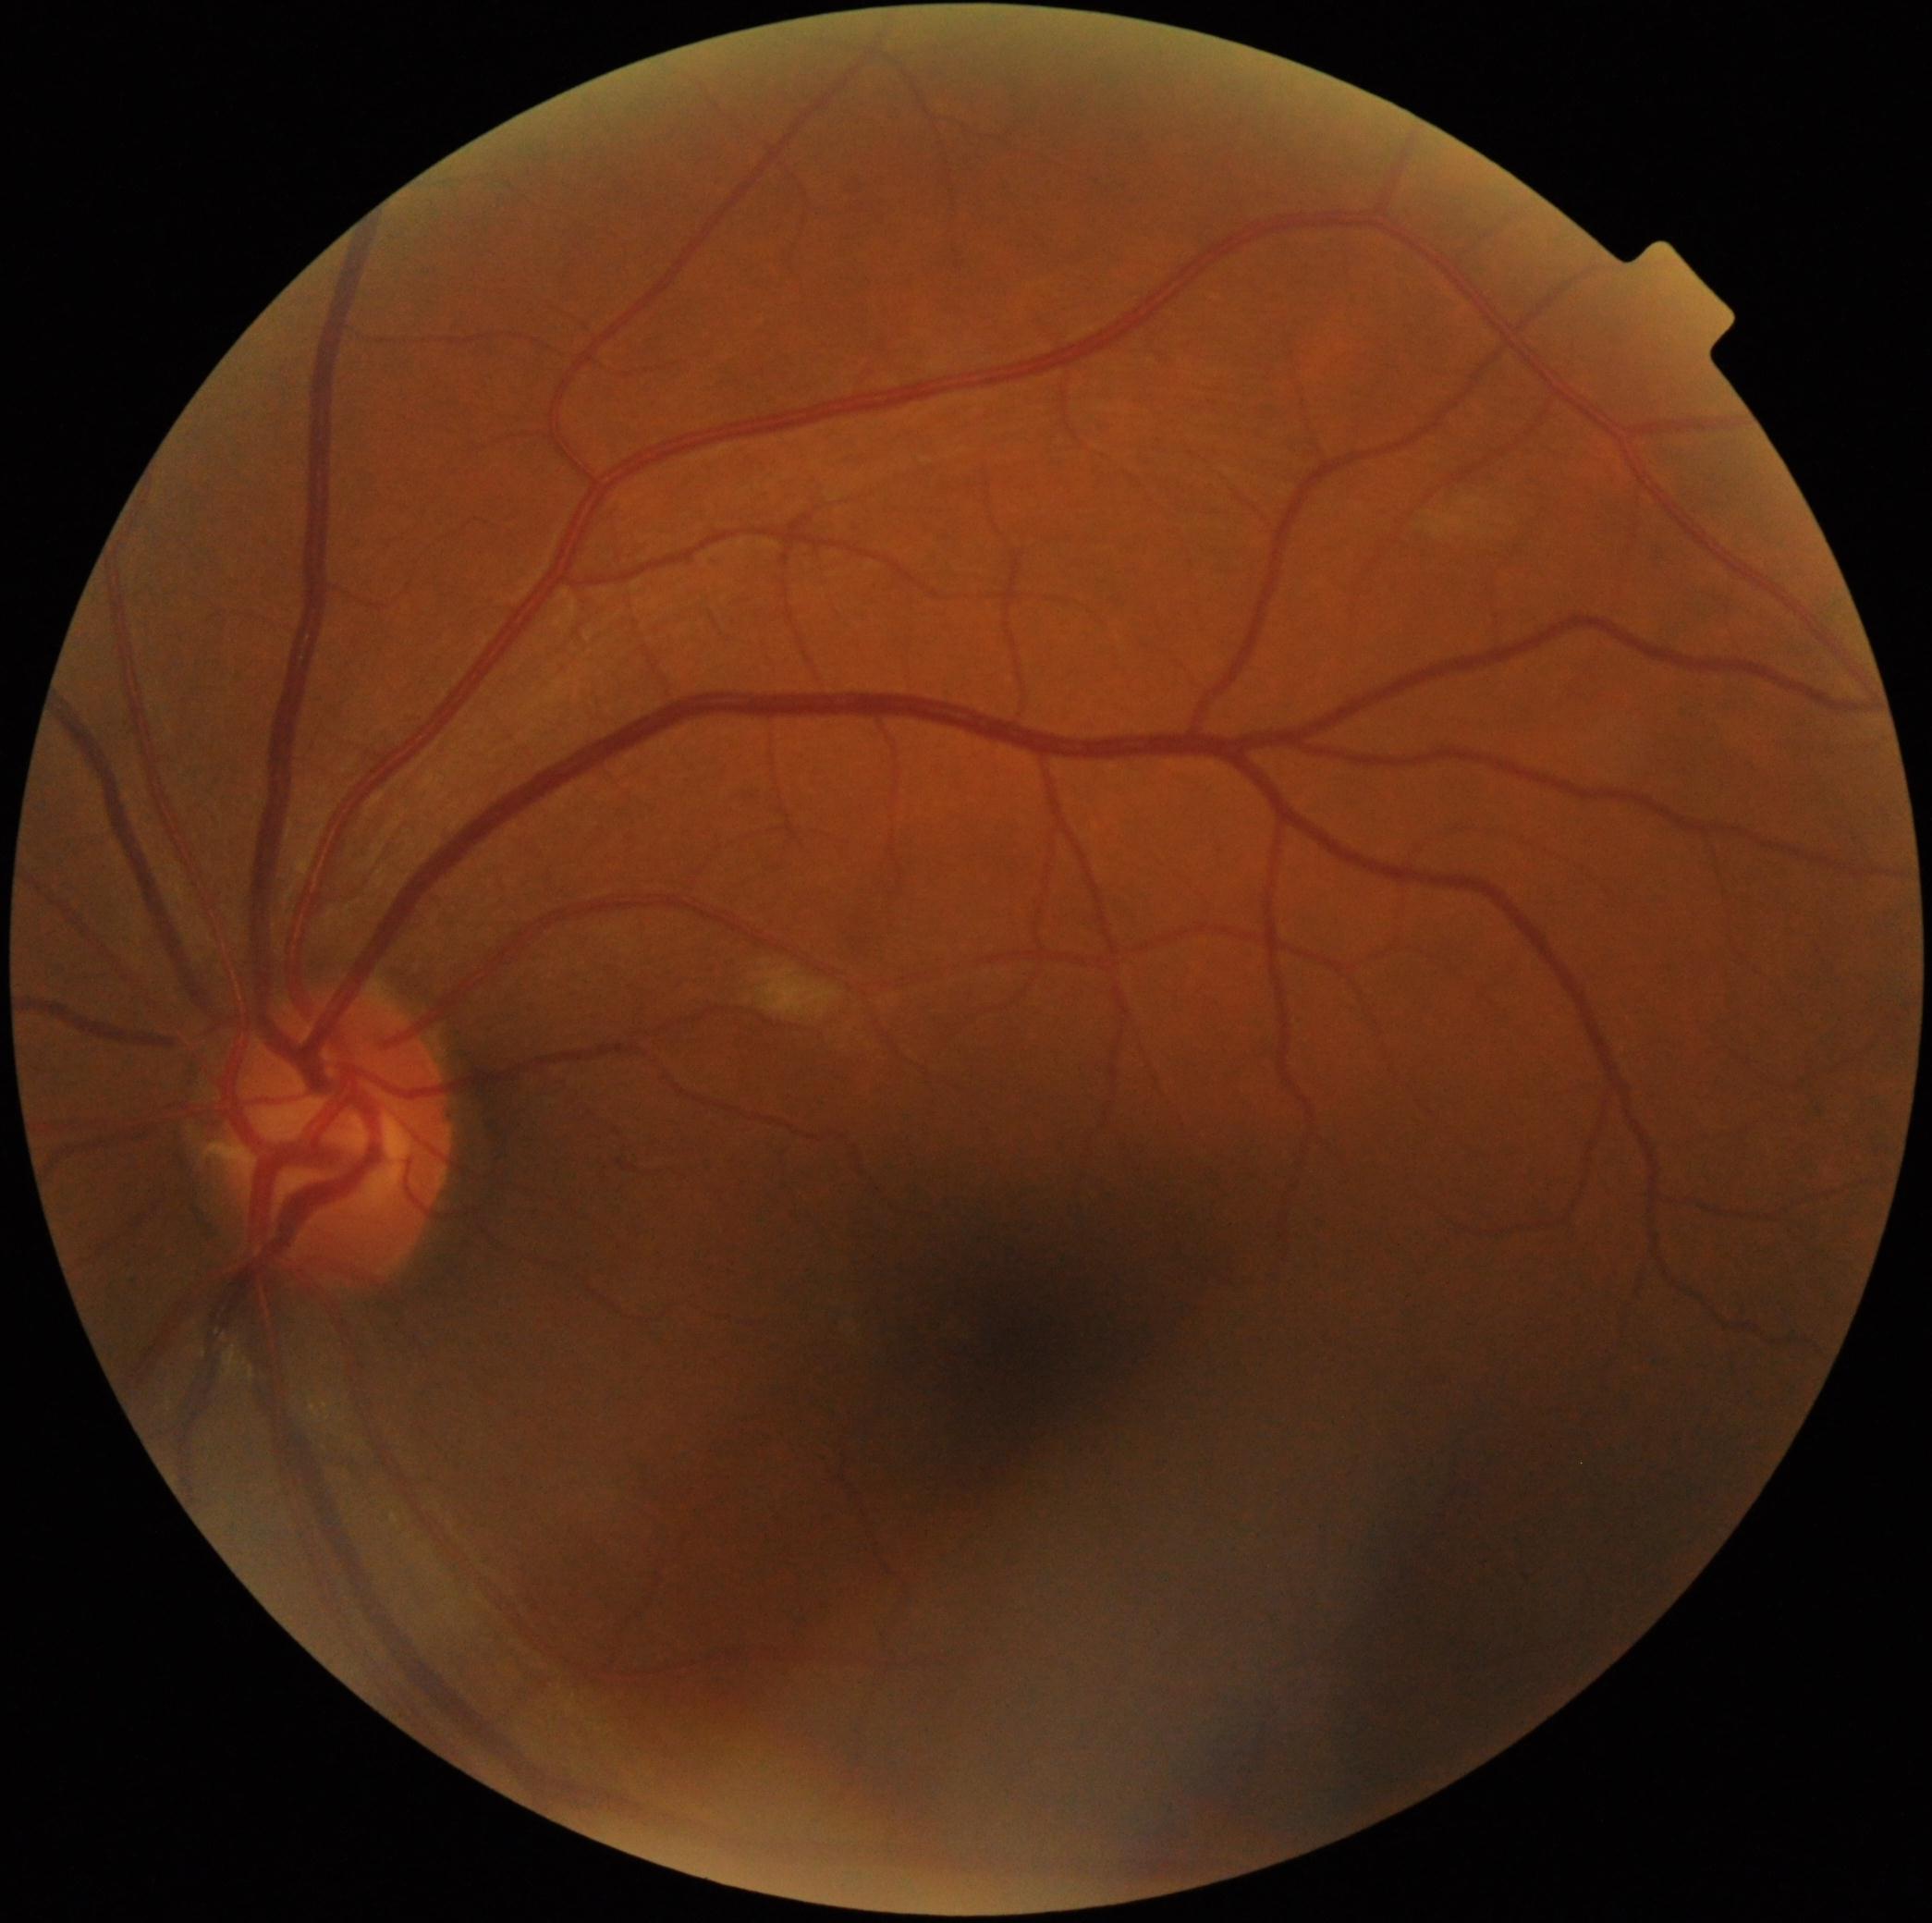

diabetic retinopathy (DR) = moderate NPDR (grade 2).